1659 by 2212 pixels
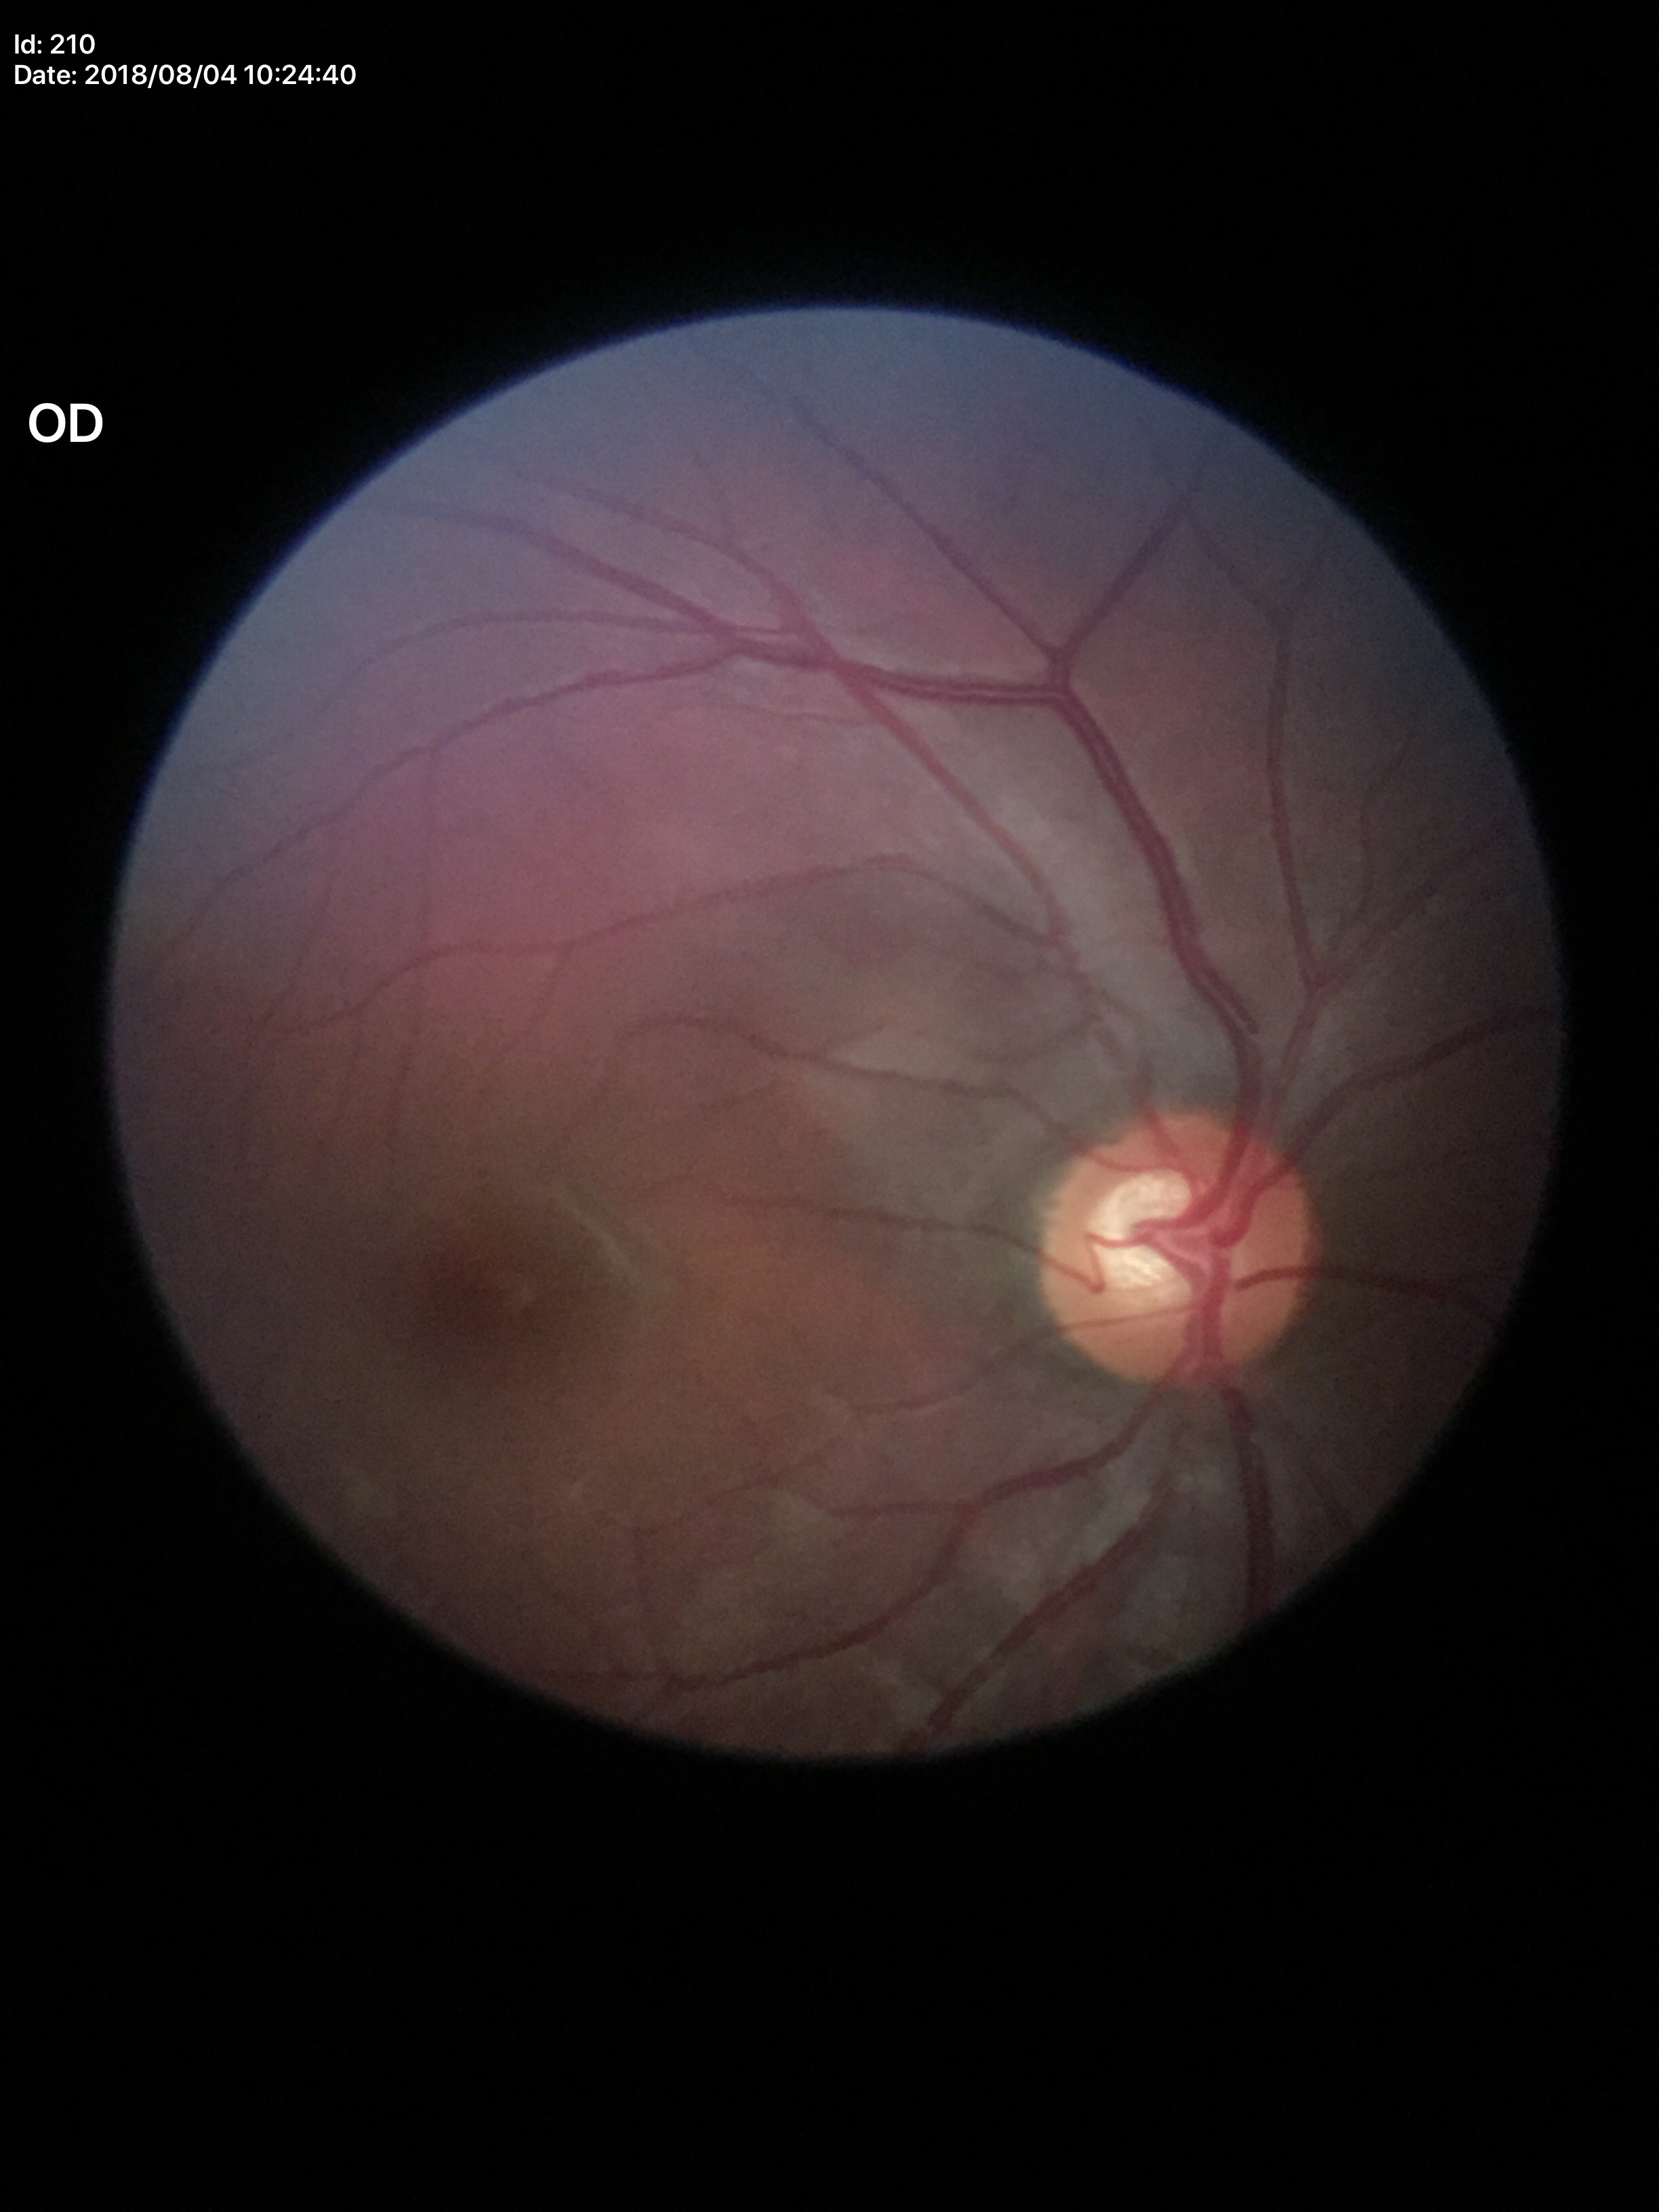
Vertical cup-disc ratio (VCDR): 0.63. Glaucoma screening impression: suspicious findings (4 of 5 graders flagged glaucoma suspect).